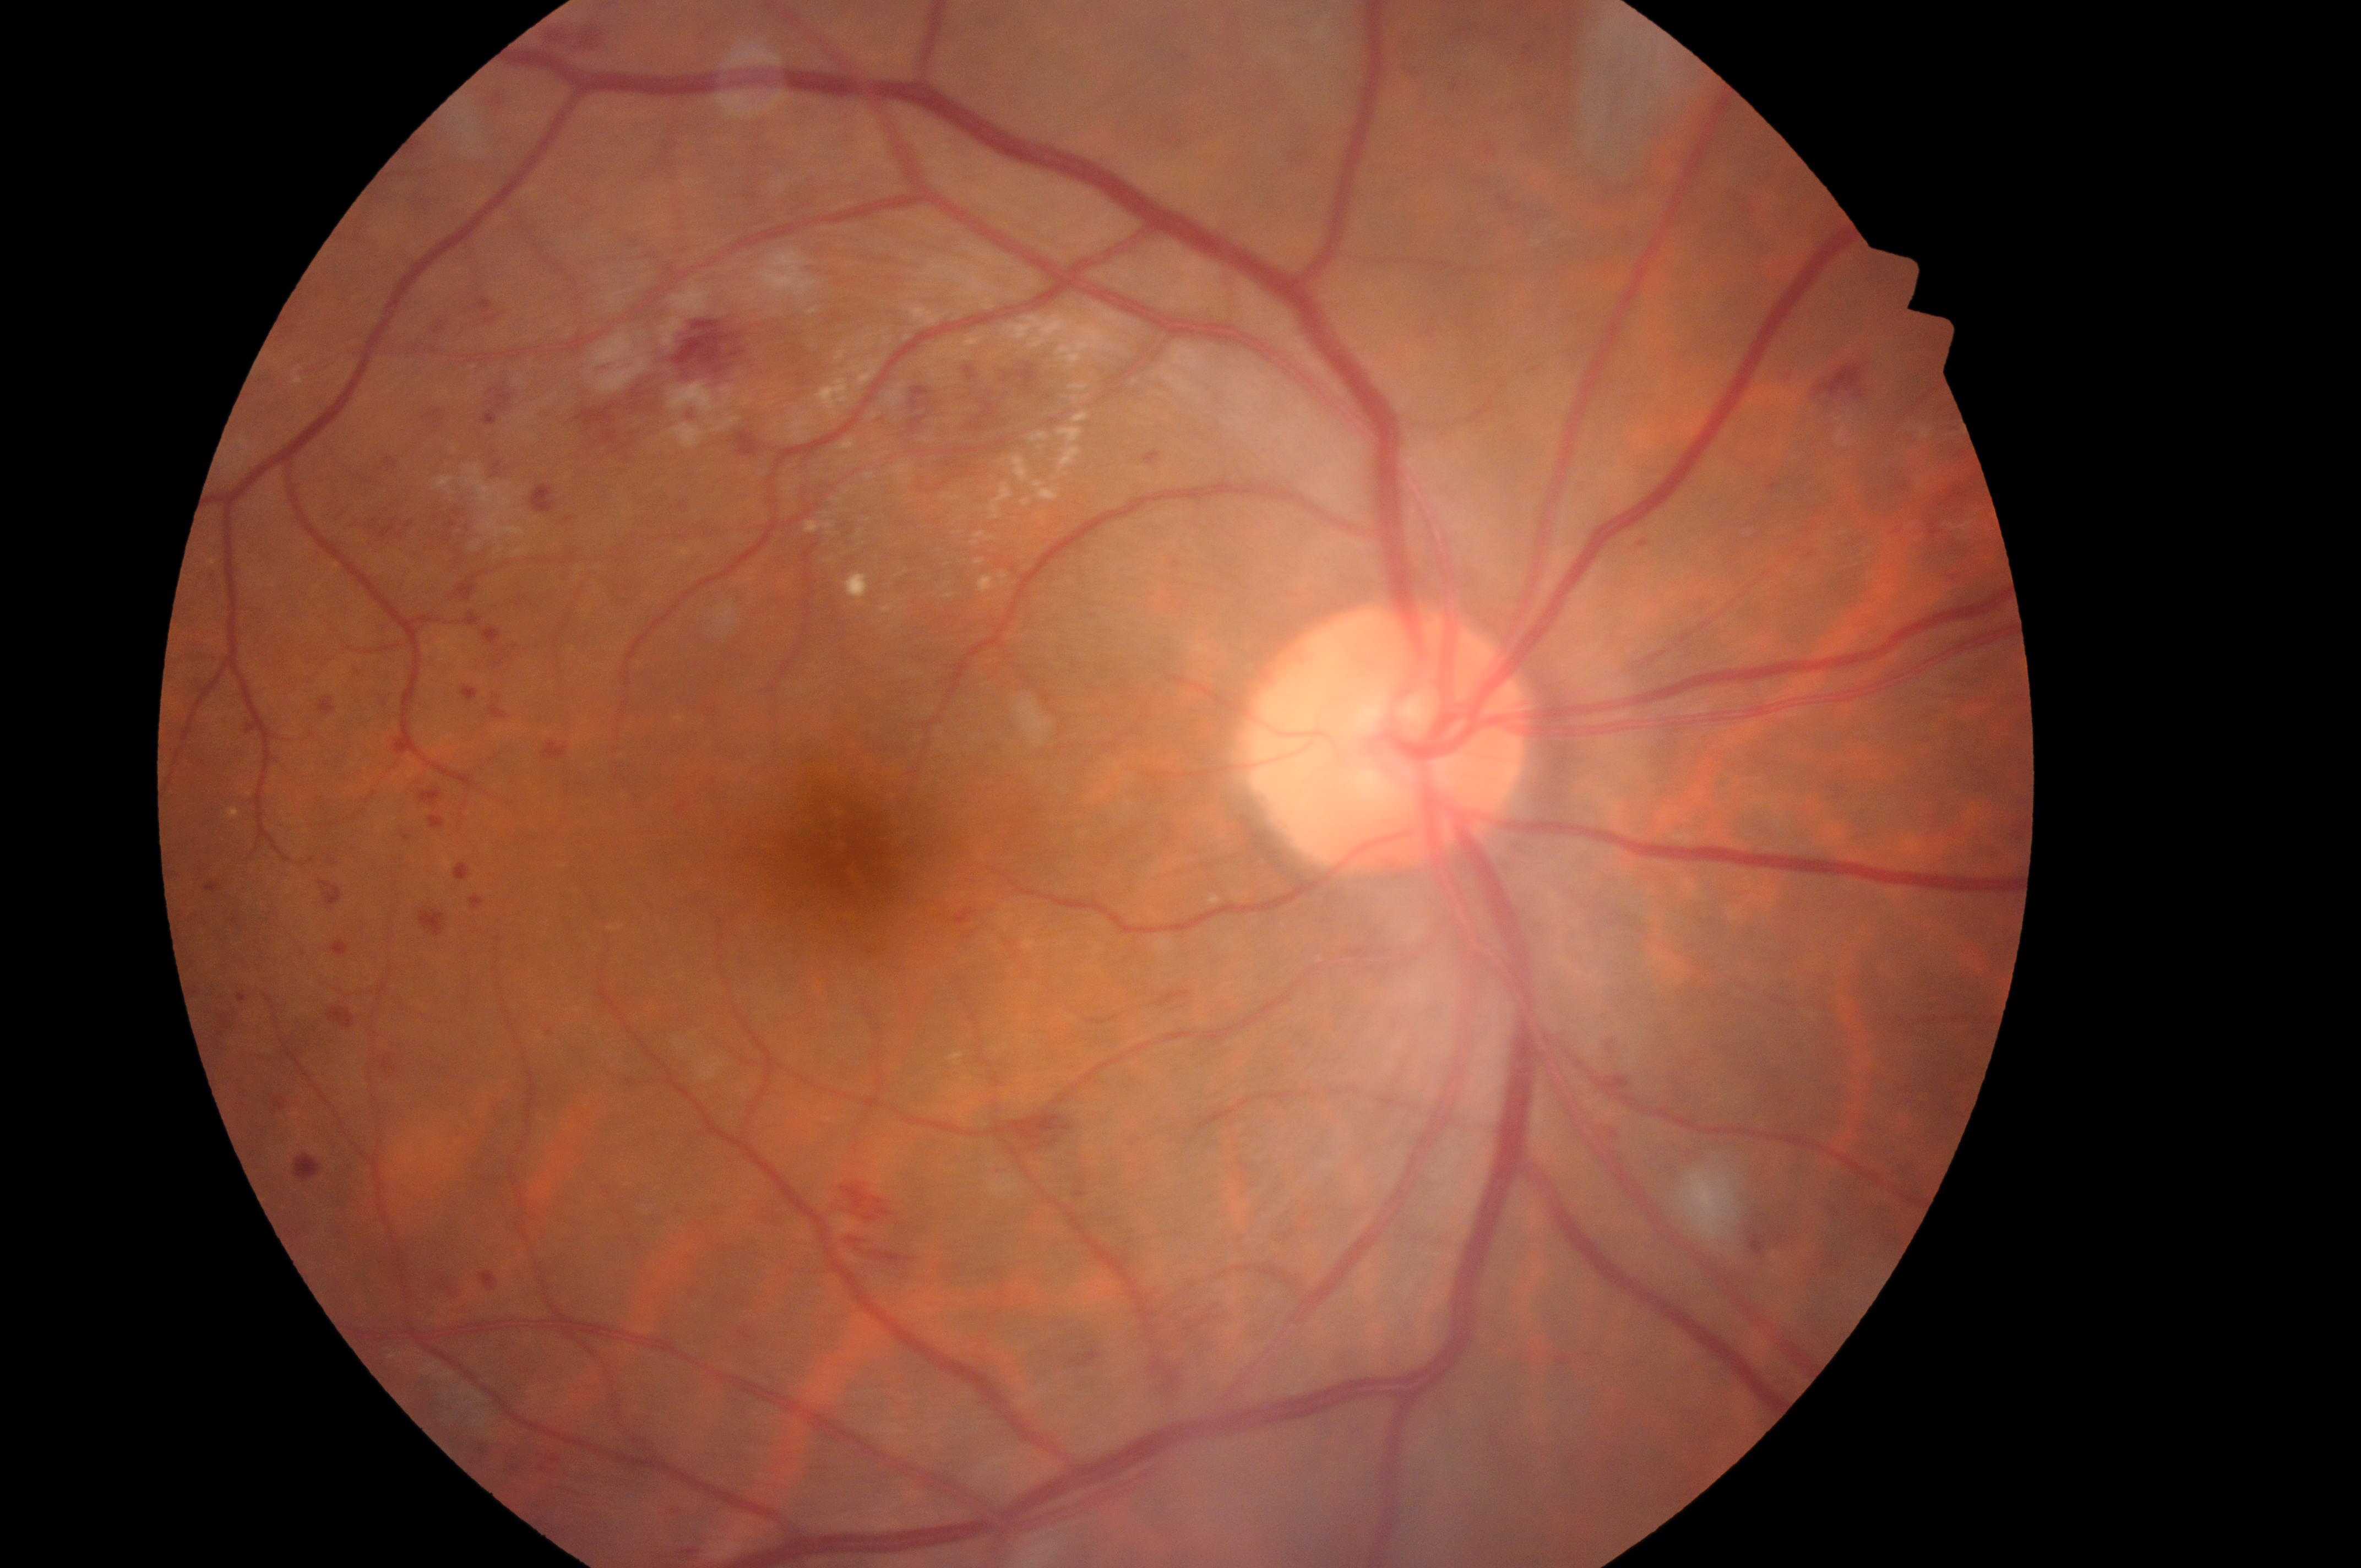   dme_grade: 1 (low risk) — hard exudates present, but outside one disc diameter of the macula center
  optic_disc: (1382,746)
  dr_grade: 3 (severe NPDR) — more than 20 intraretinal hemorrhages in each of 4 quadrants, definite venous beading in 2 or more quadrants, or prominent intraretinal microvascular abnormalities in 1 or more quadrants, with no signs of proliferative retinopathy
  eye: right eye
  fovea: (852,864)
  dr_category: non-proliferative diabetic retinopathy